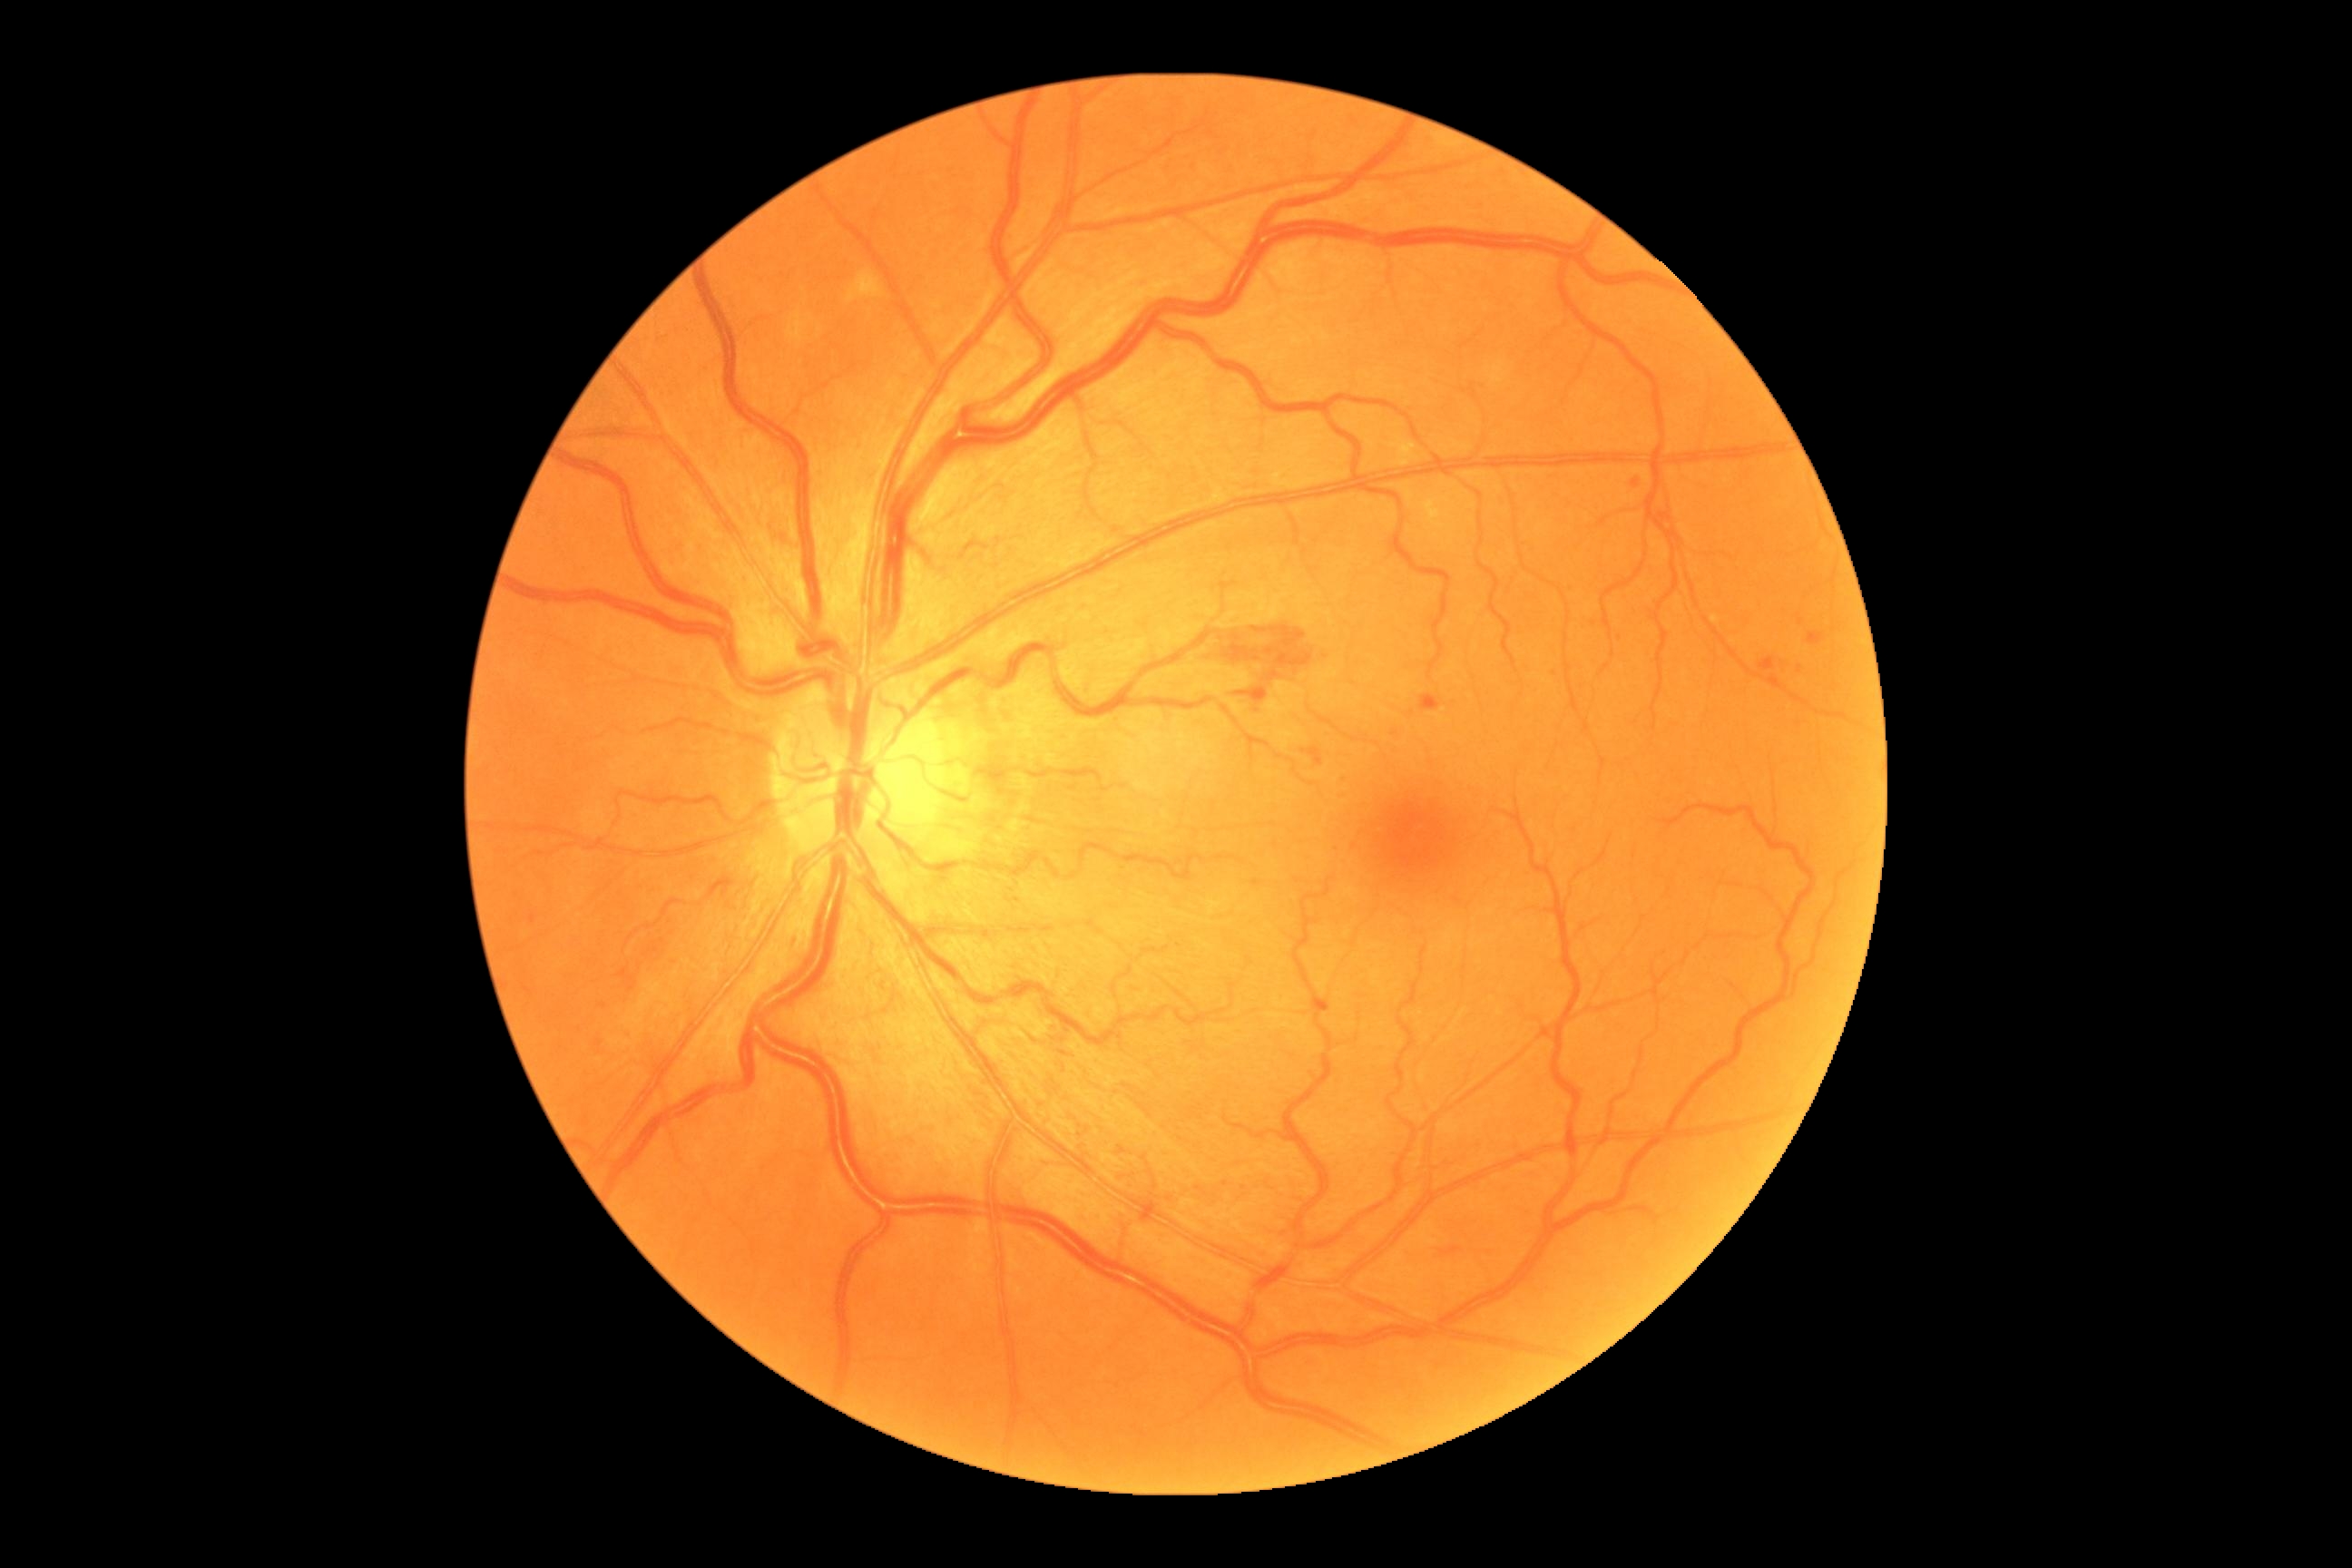

Findings:
- retinopathy grade: 2 (moderate NPDR)